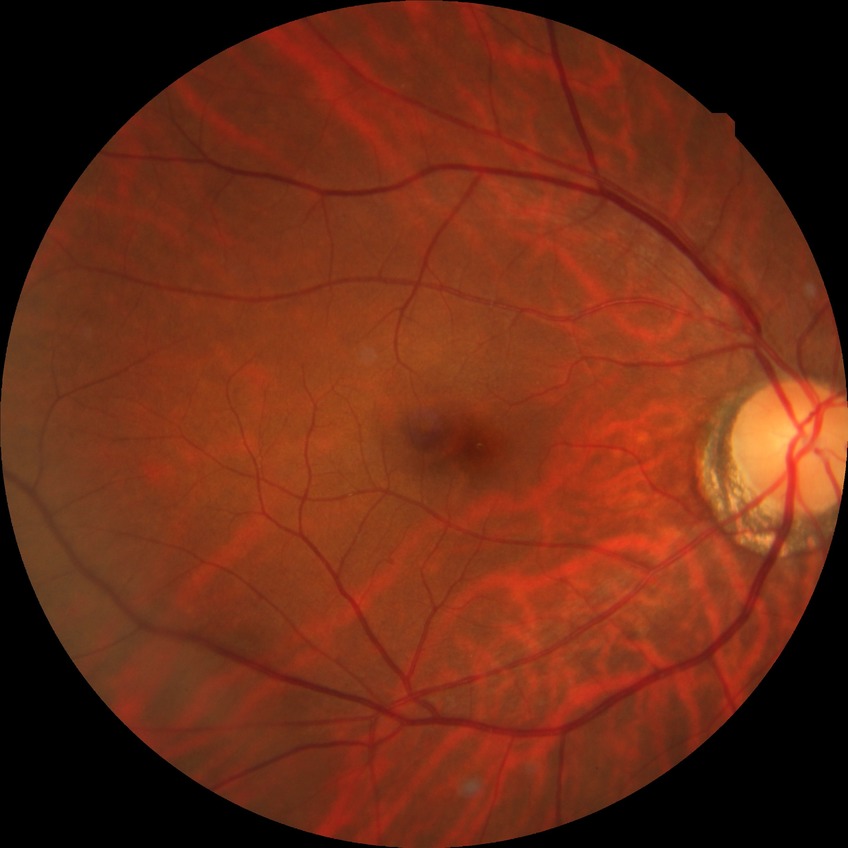 DR is NDR.